45° field of view — 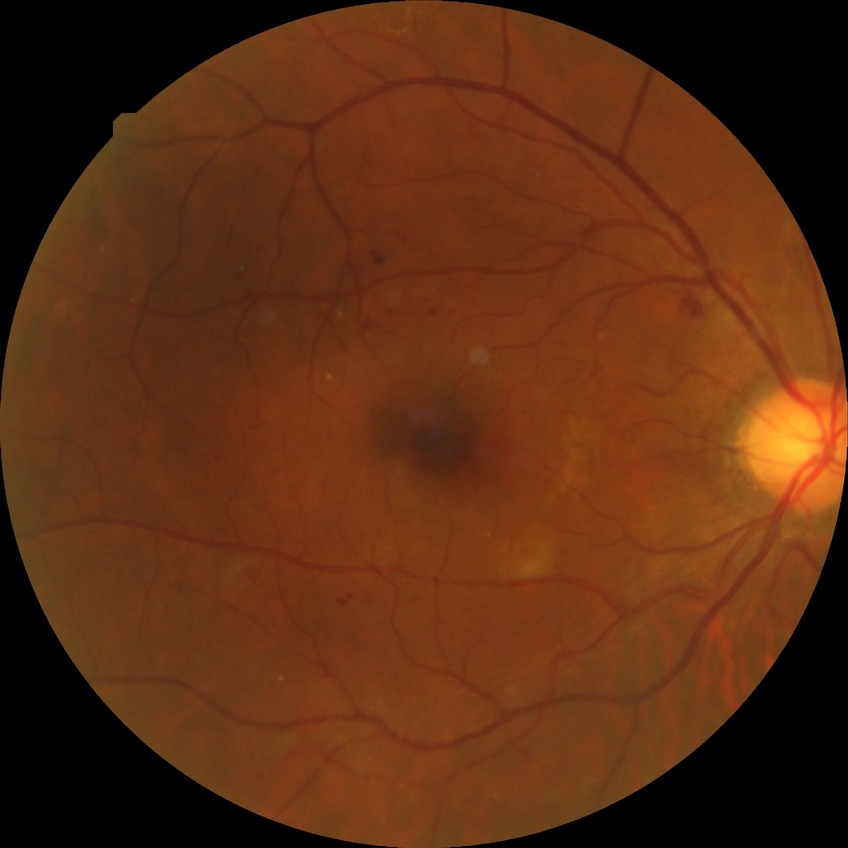

Diabetic retinopathy severity: simple diabetic retinopathy.